2352 x 1568 pixels. 45° FOV:
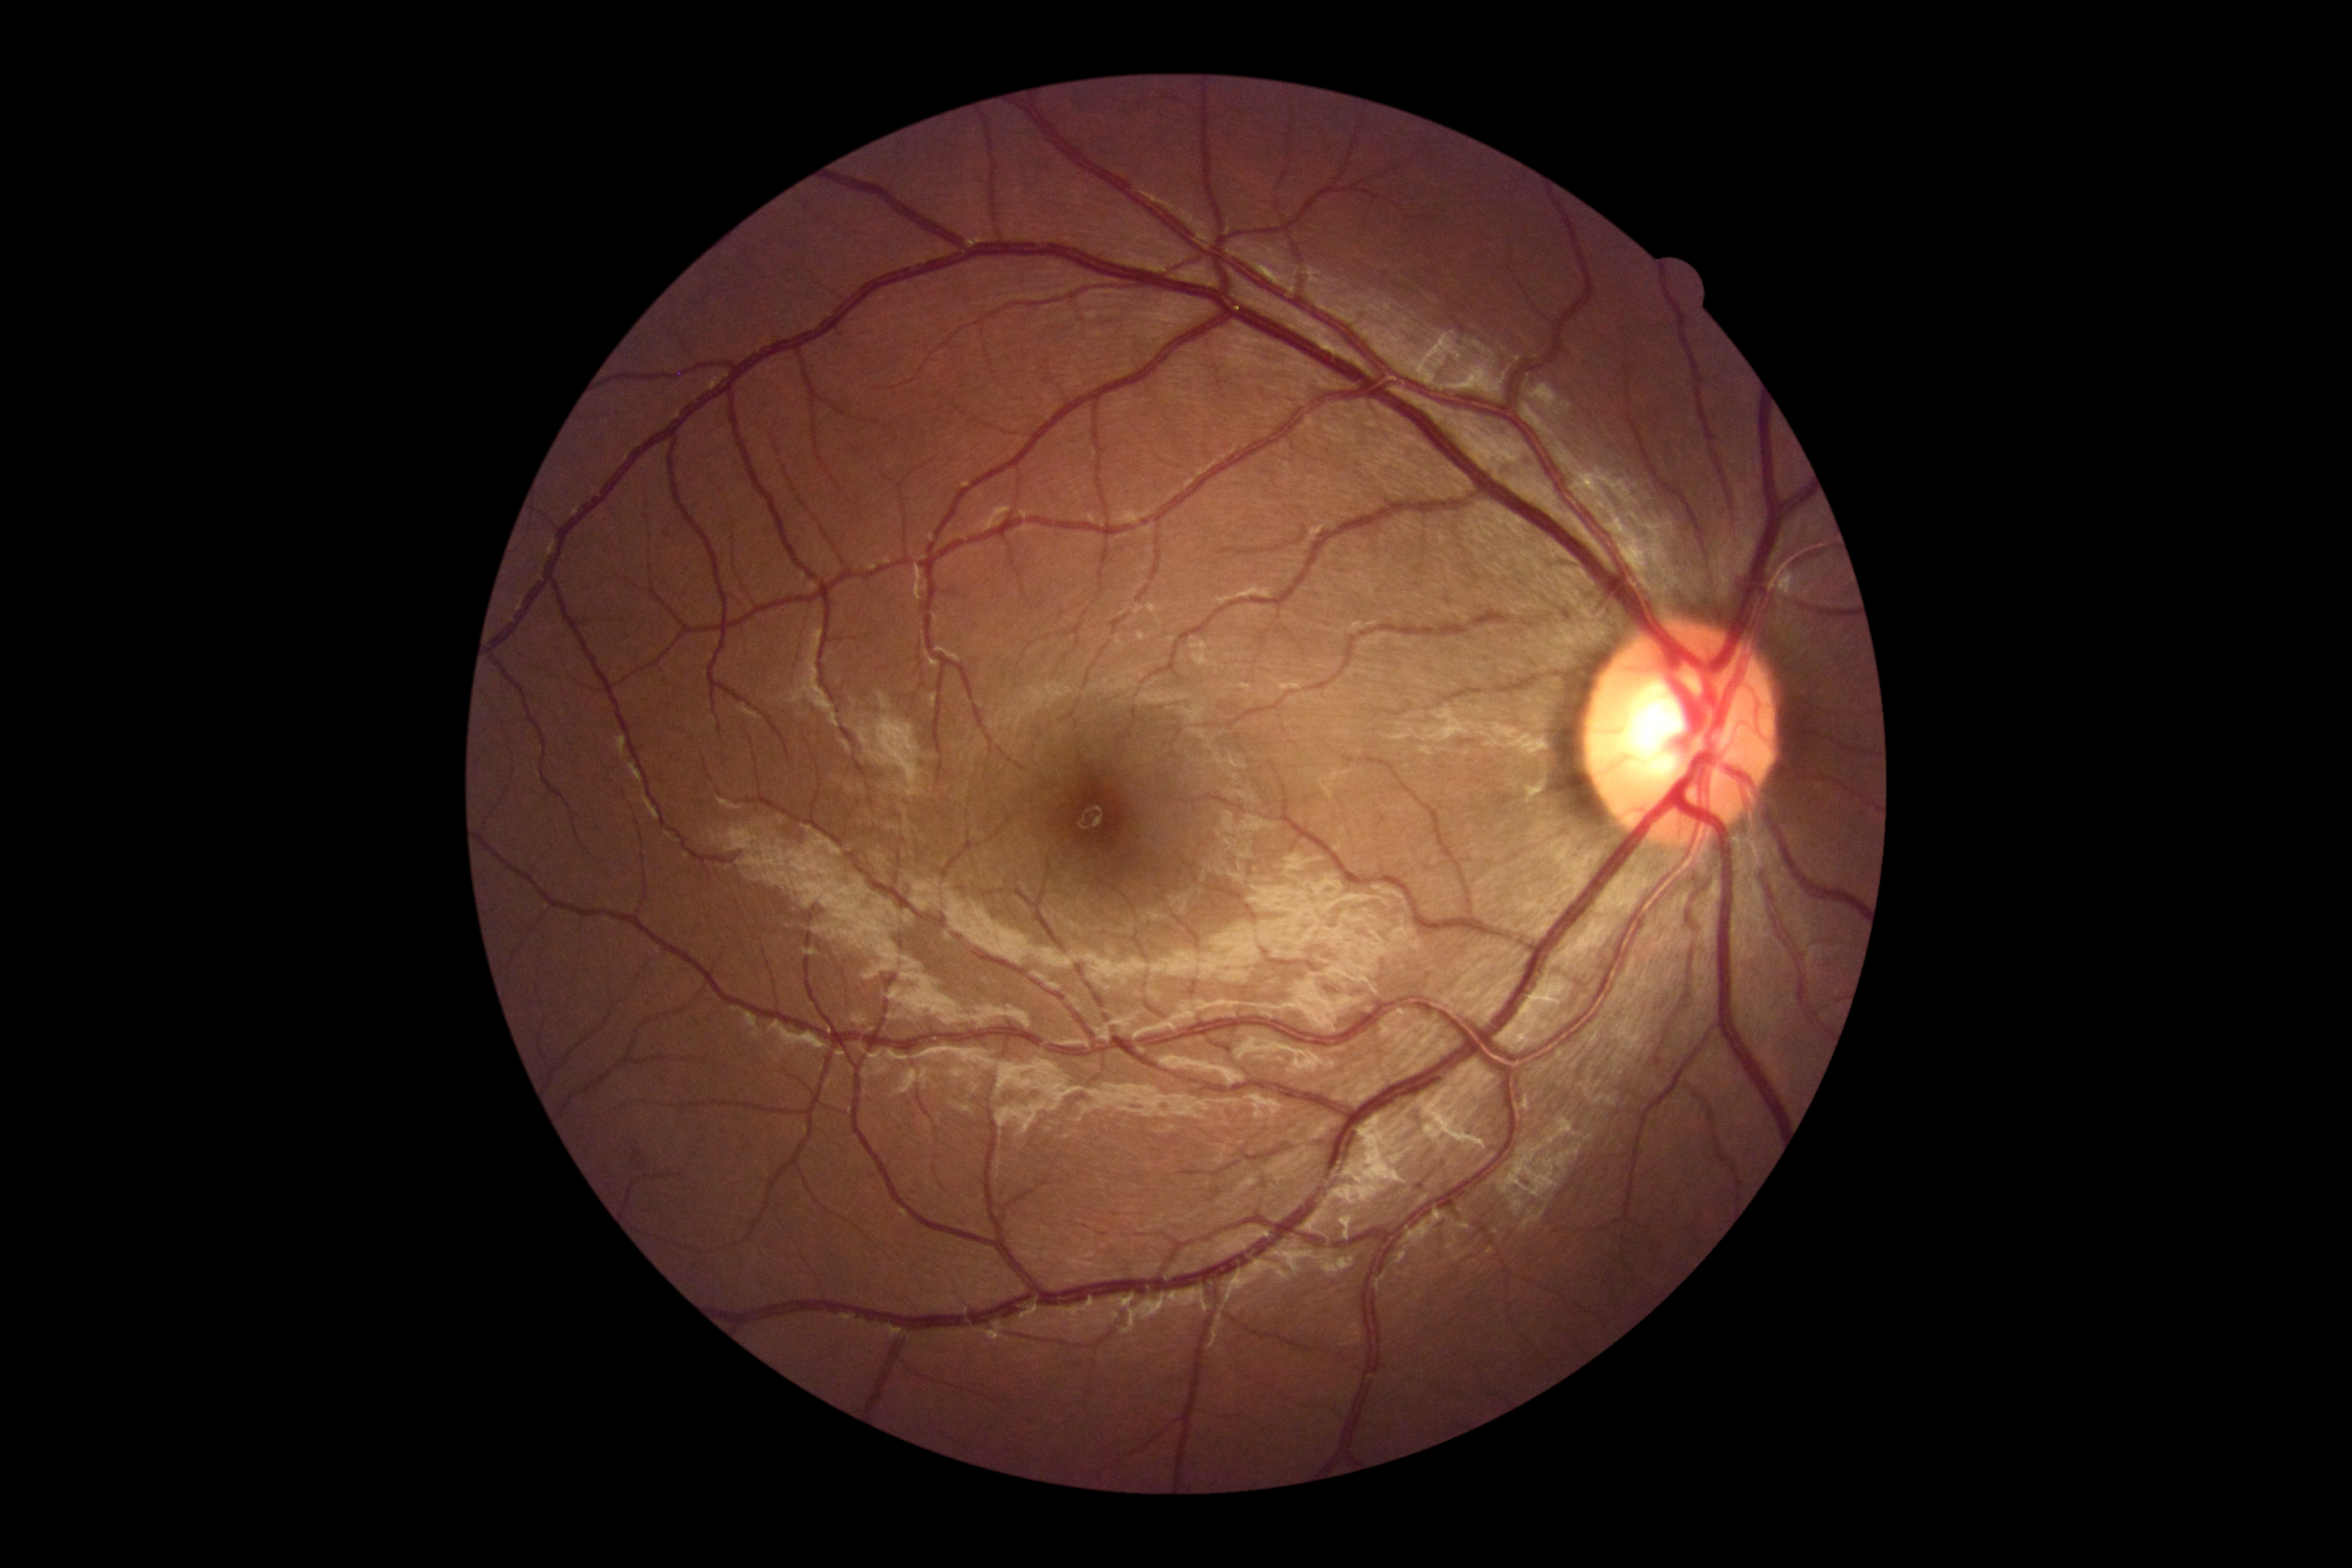

DR grade: 0.